45° field of view
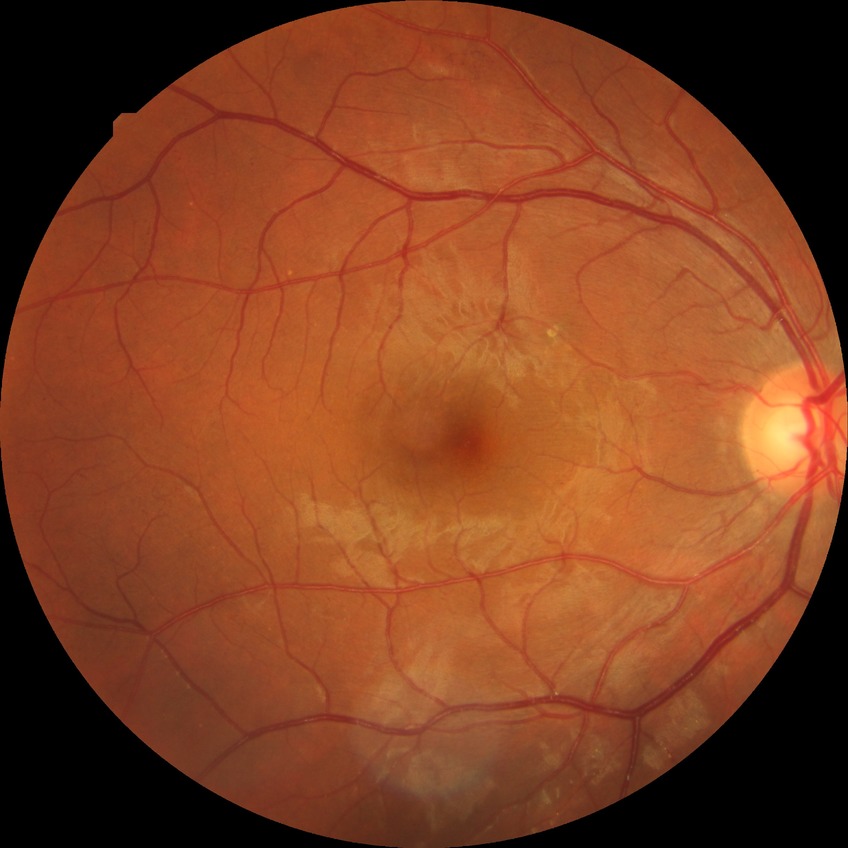

diabetic retinopathy (DR) = pre-proliferative diabetic retinopathy (PPDR), DR class = non-proliferative diabetic retinopathy.